Topcon TRC-50DX. Posterior pole field covering the optic disc and macula
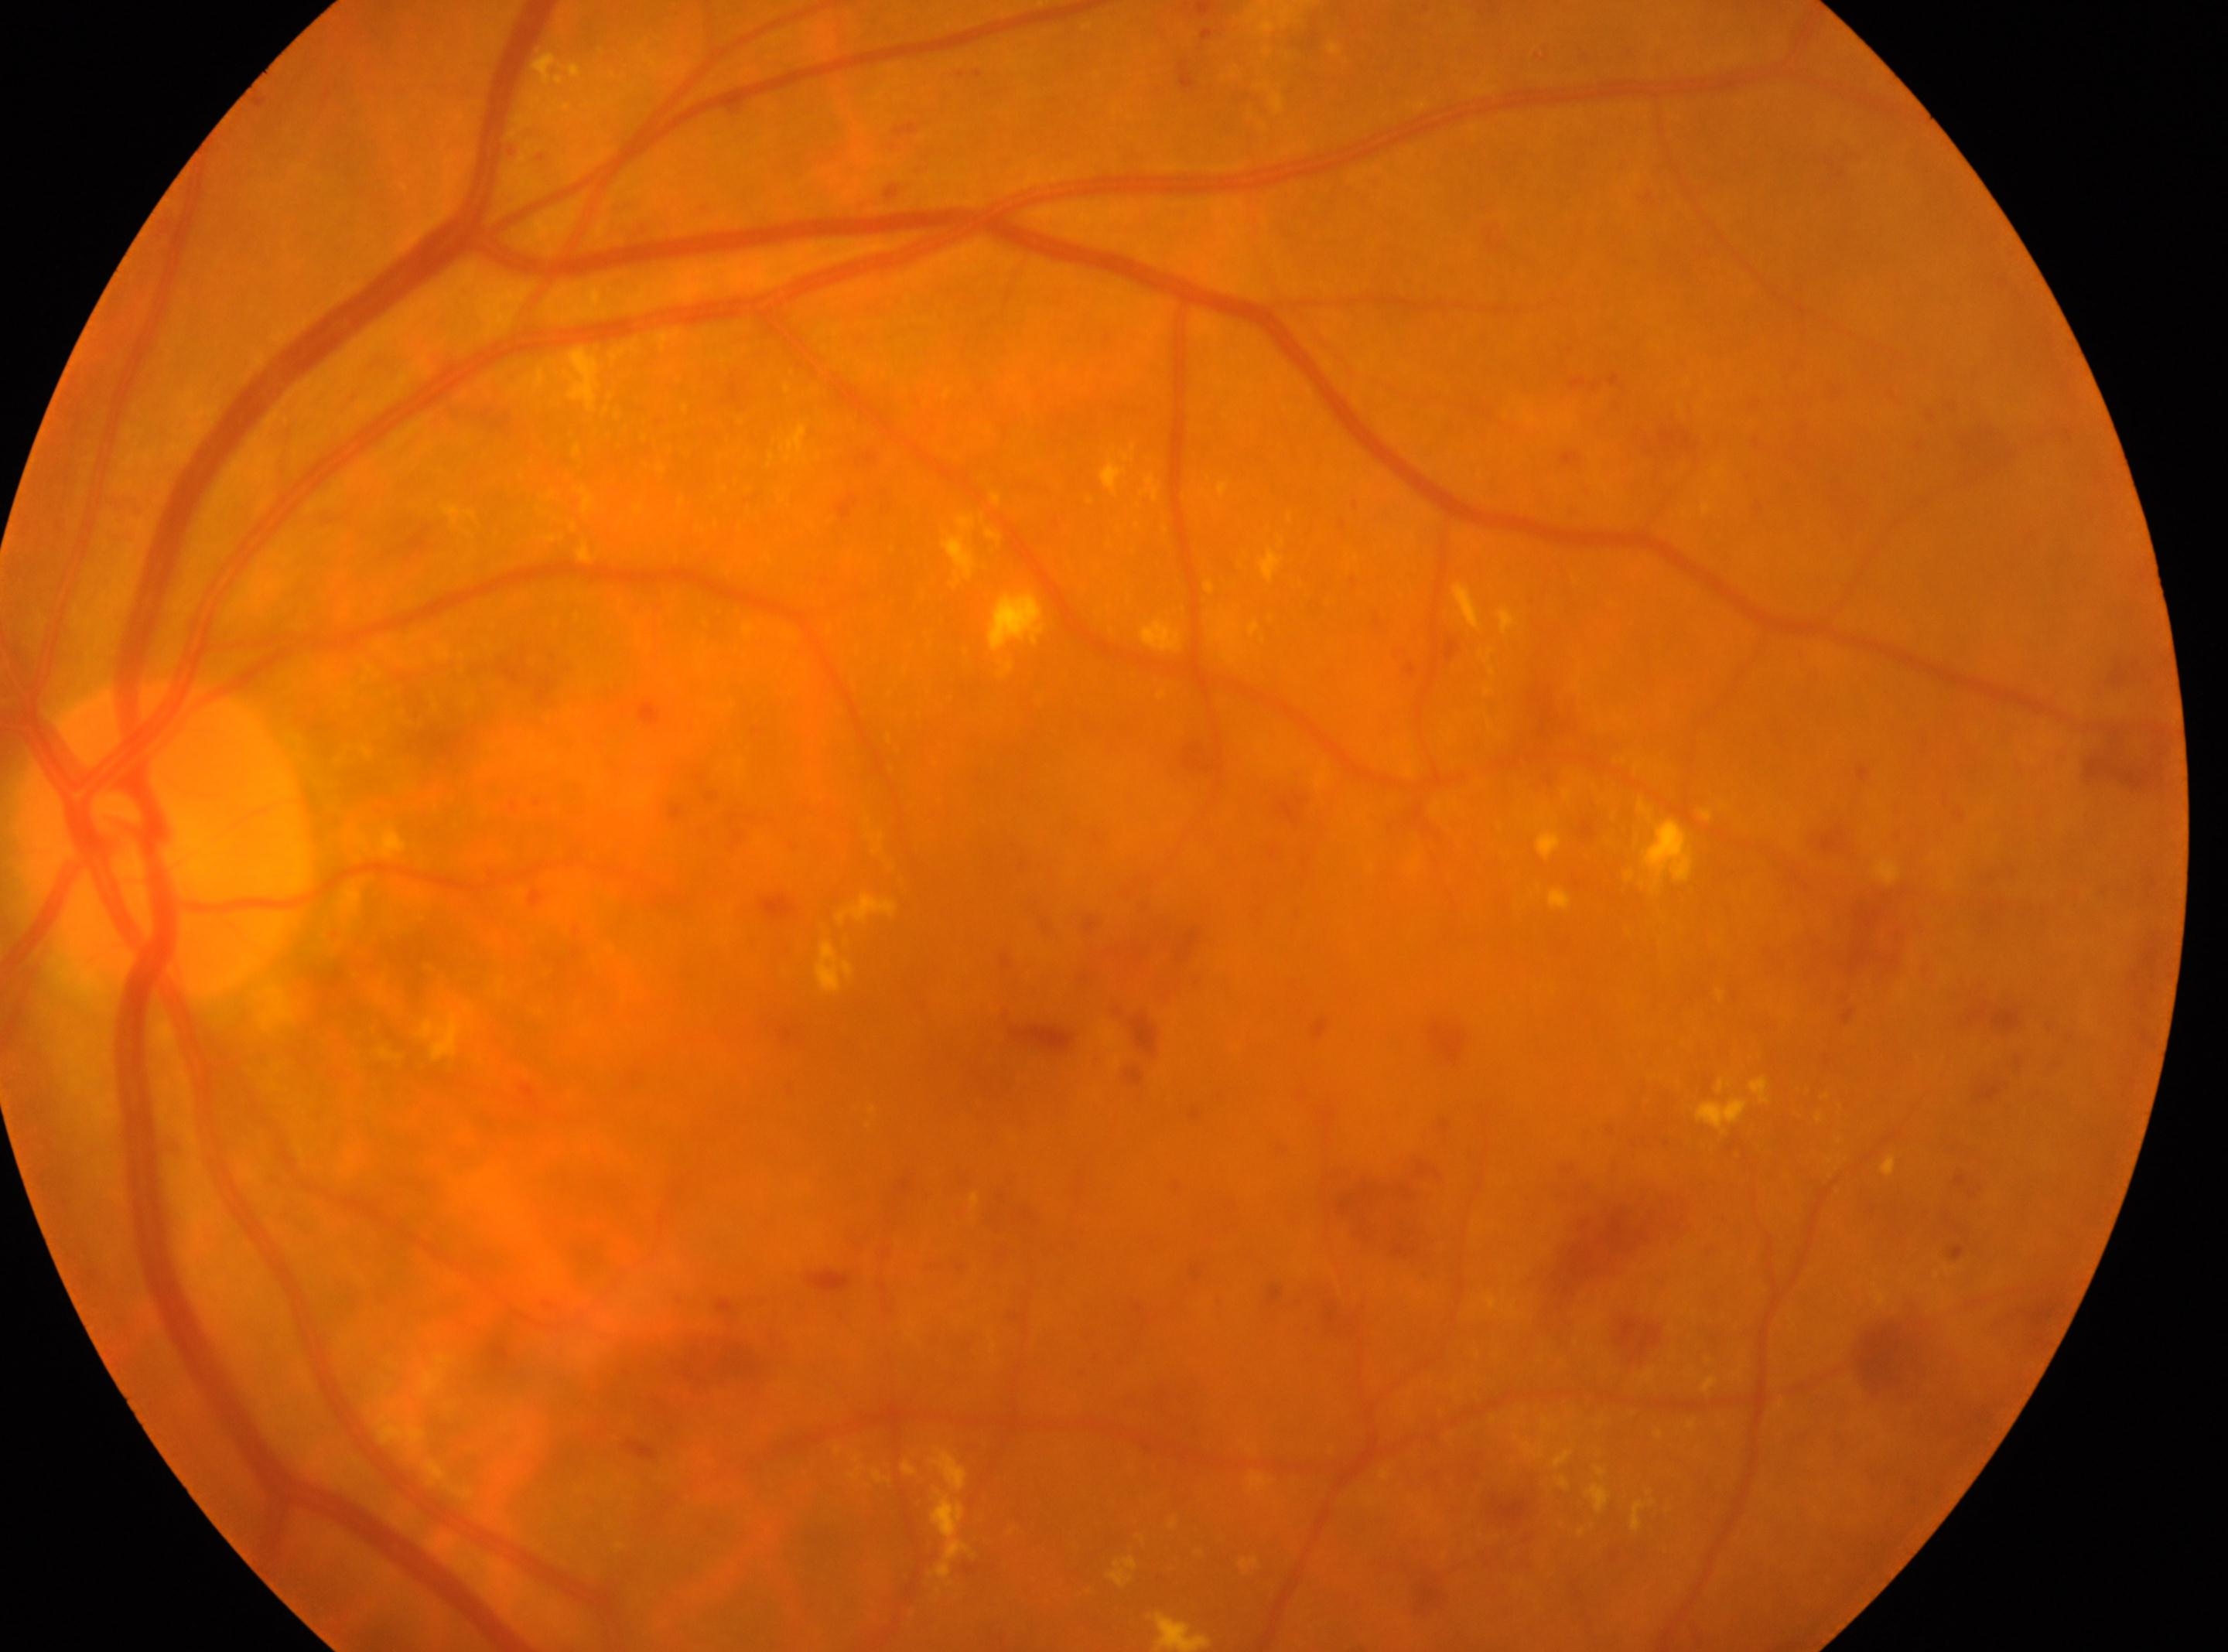
This is the left eye.
DR is grade 3 (severe NPDR).
Optic nerve head: (x=165, y=838).
The fovea is at (x=993, y=1049).